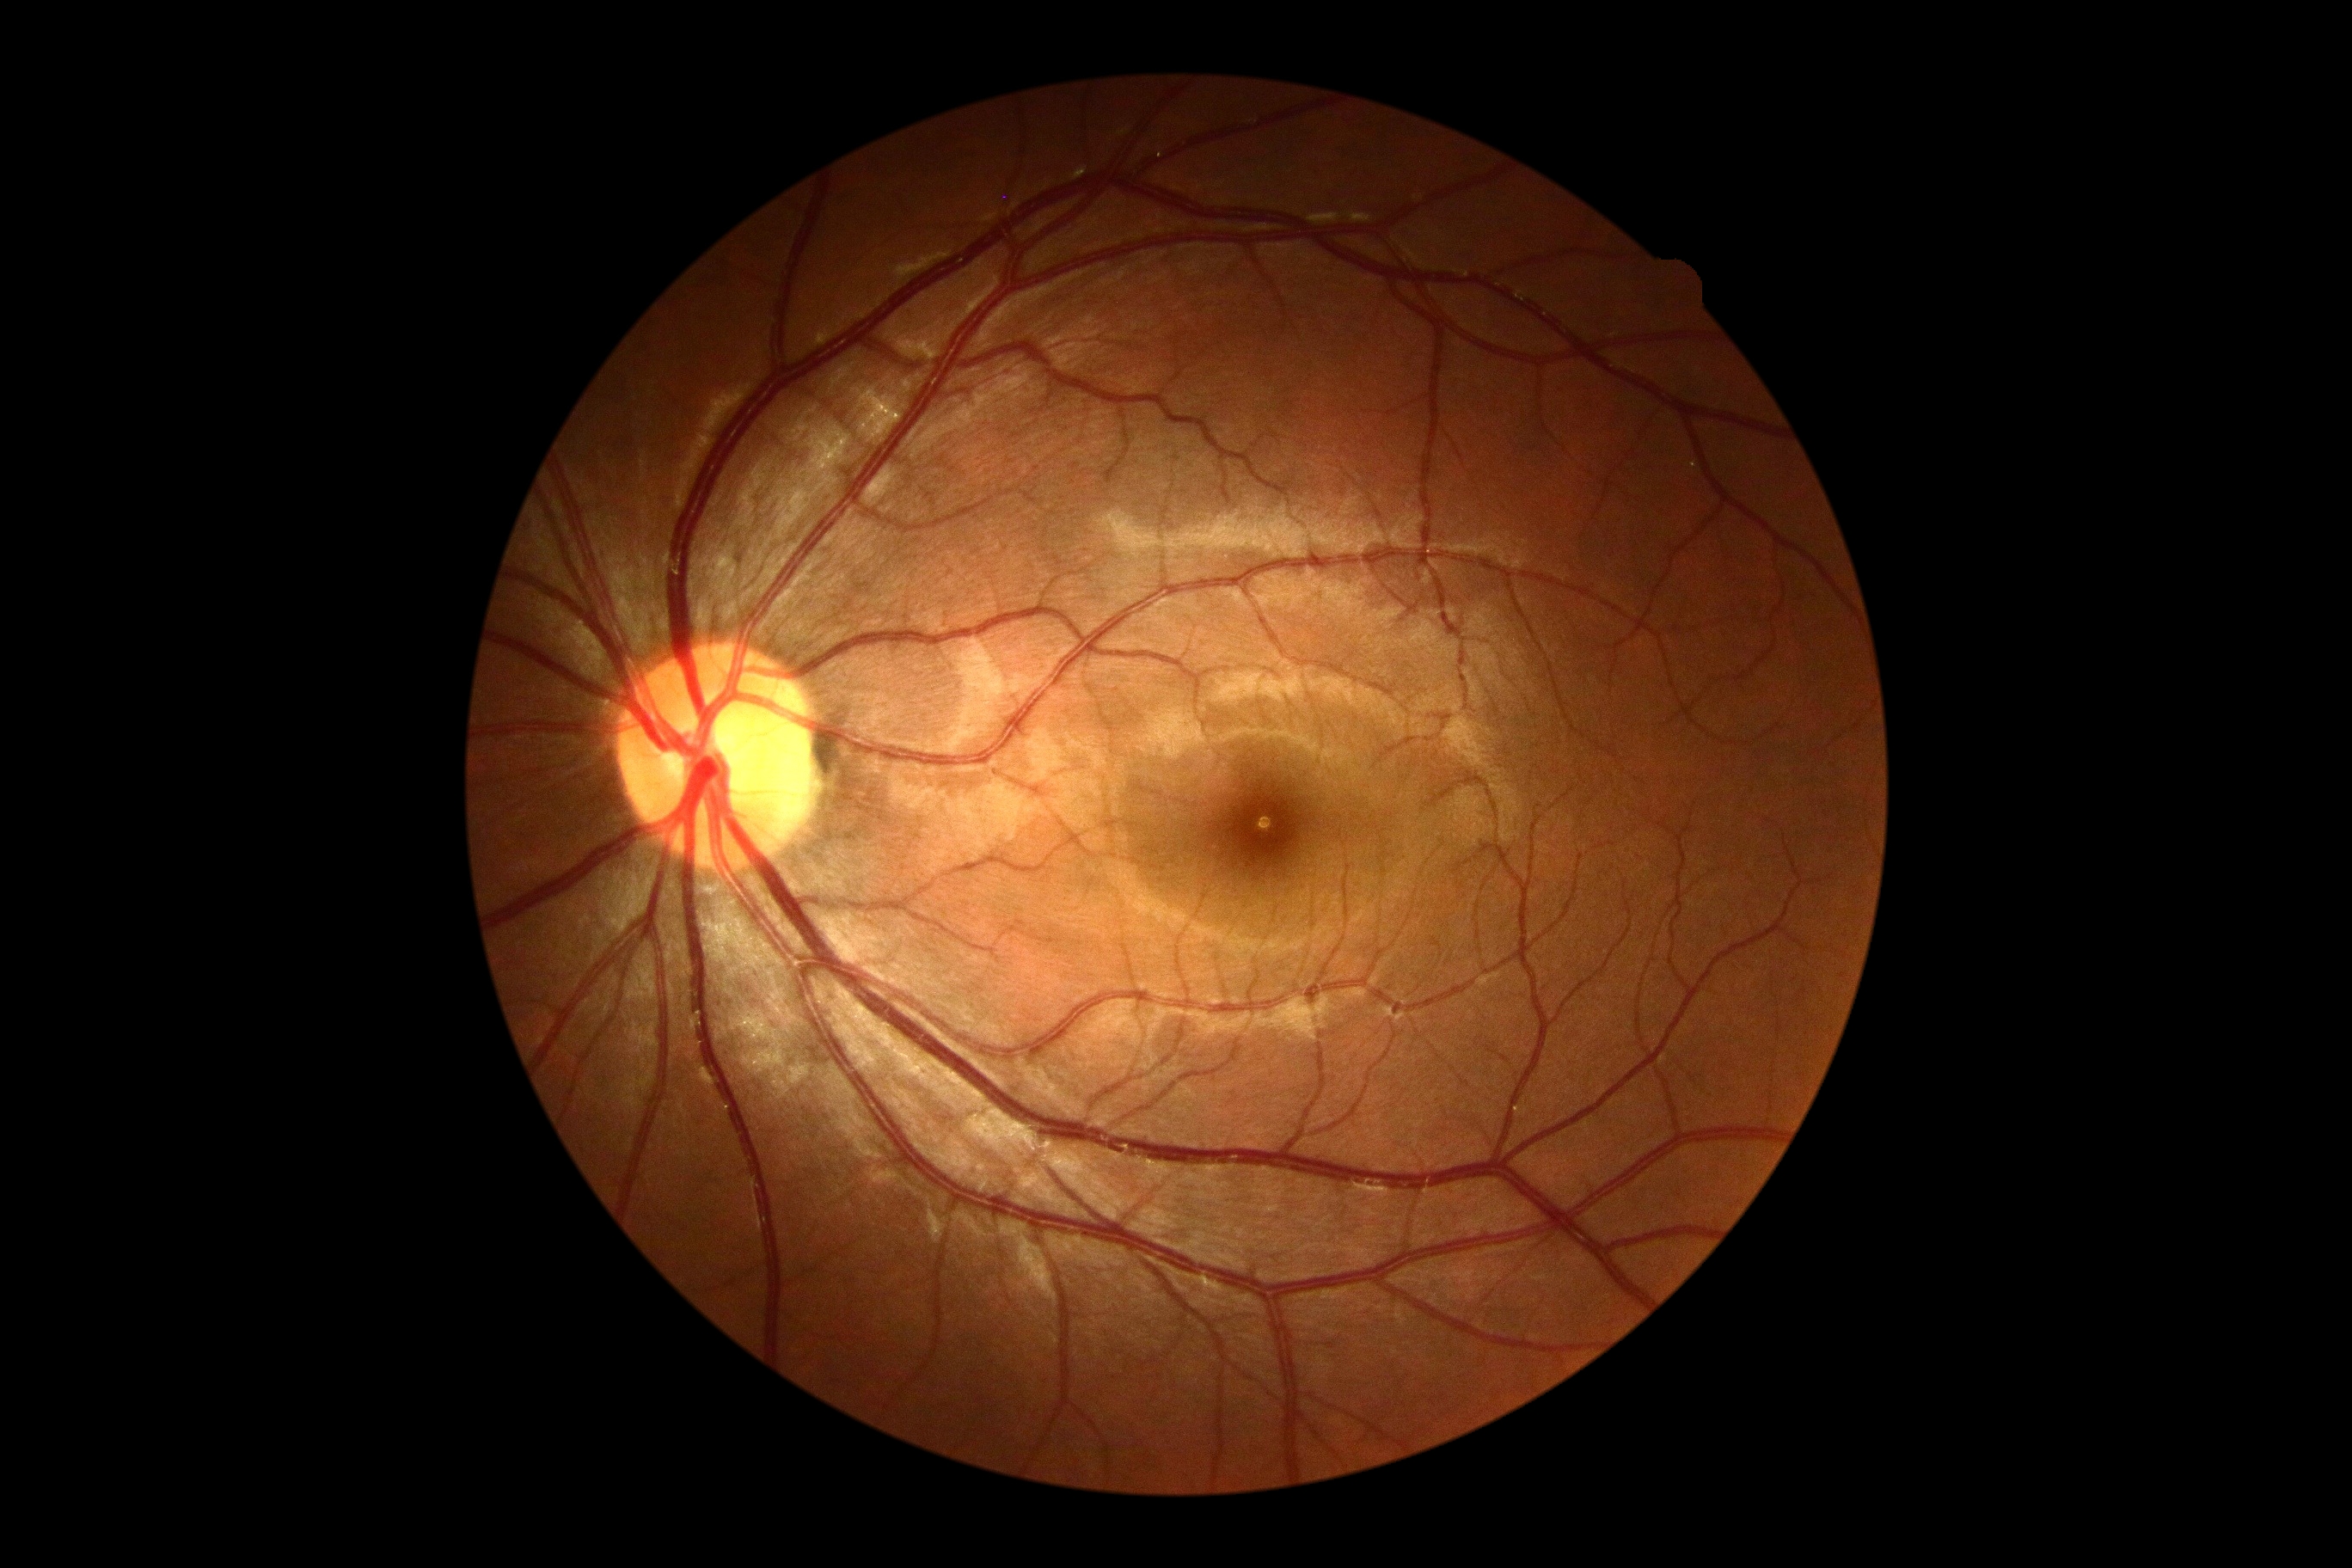 DR impression = no apparent DR, DR grade = 0 (no apparent retinopathy) — no visible signs of diabetic retinopathy.